Infant wide-field fundus photograph; image size 1240x1240 — 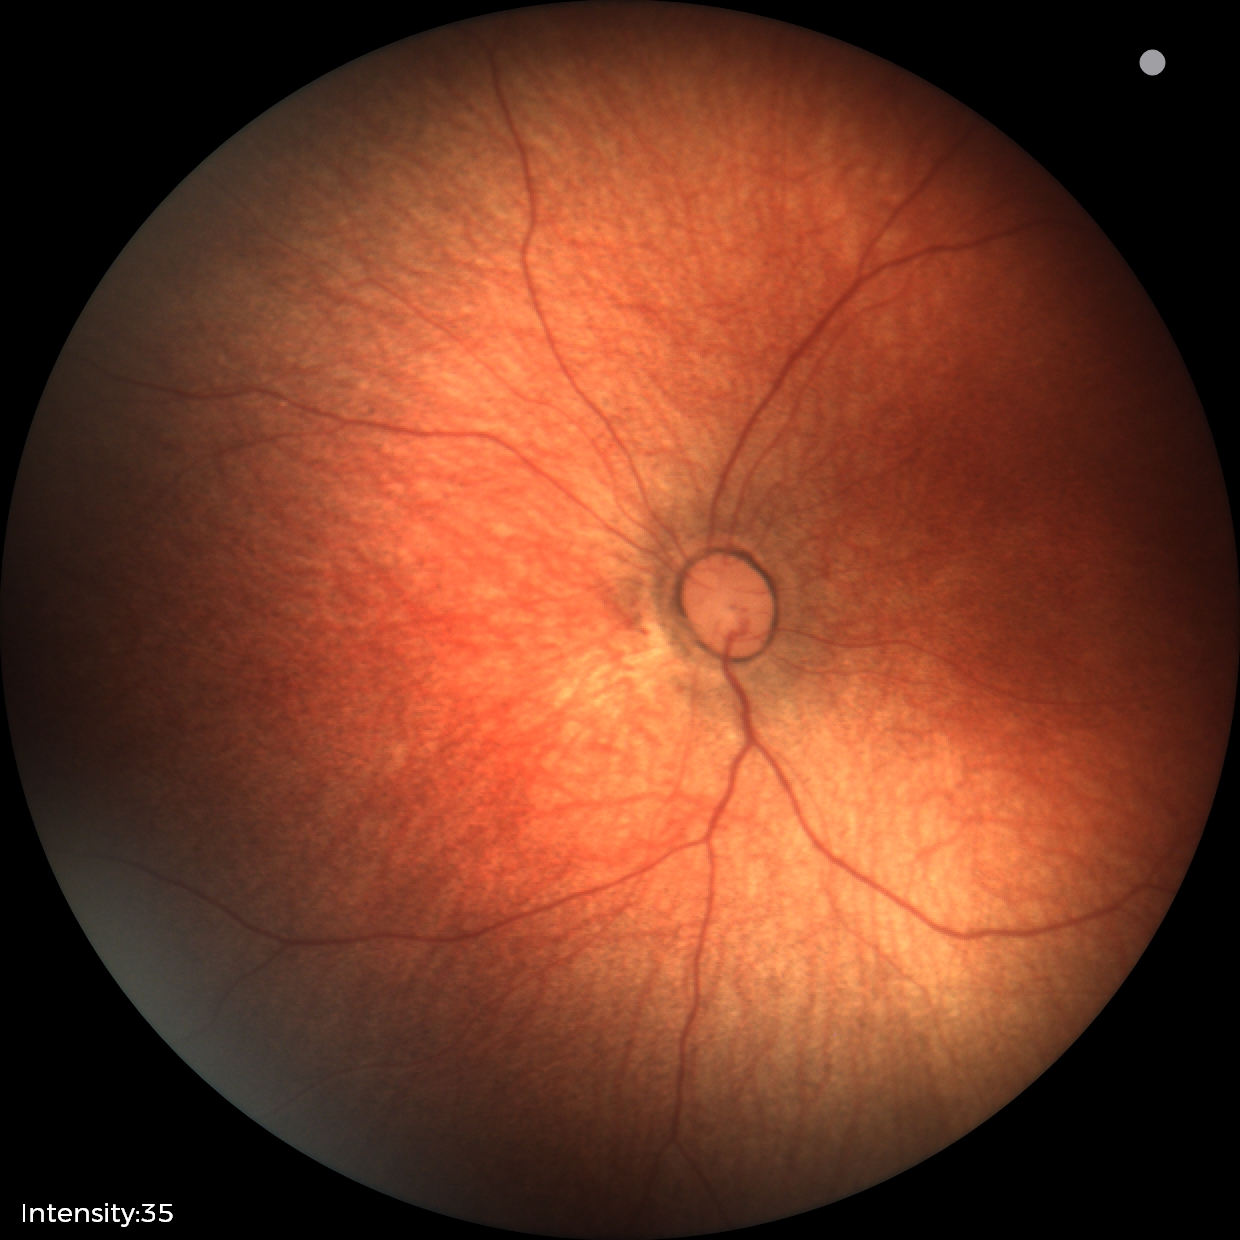
Screening examination diagnosed as physiological.